Color fundus photograph · camera: Nidek AFC-330 — 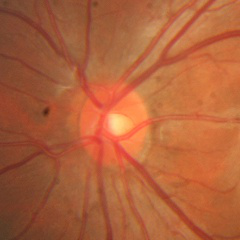

Q: Is glaucoma present?
A: No — no glaucomatous findings.